Wide-field fundus photograph from neonatal ROP screening.
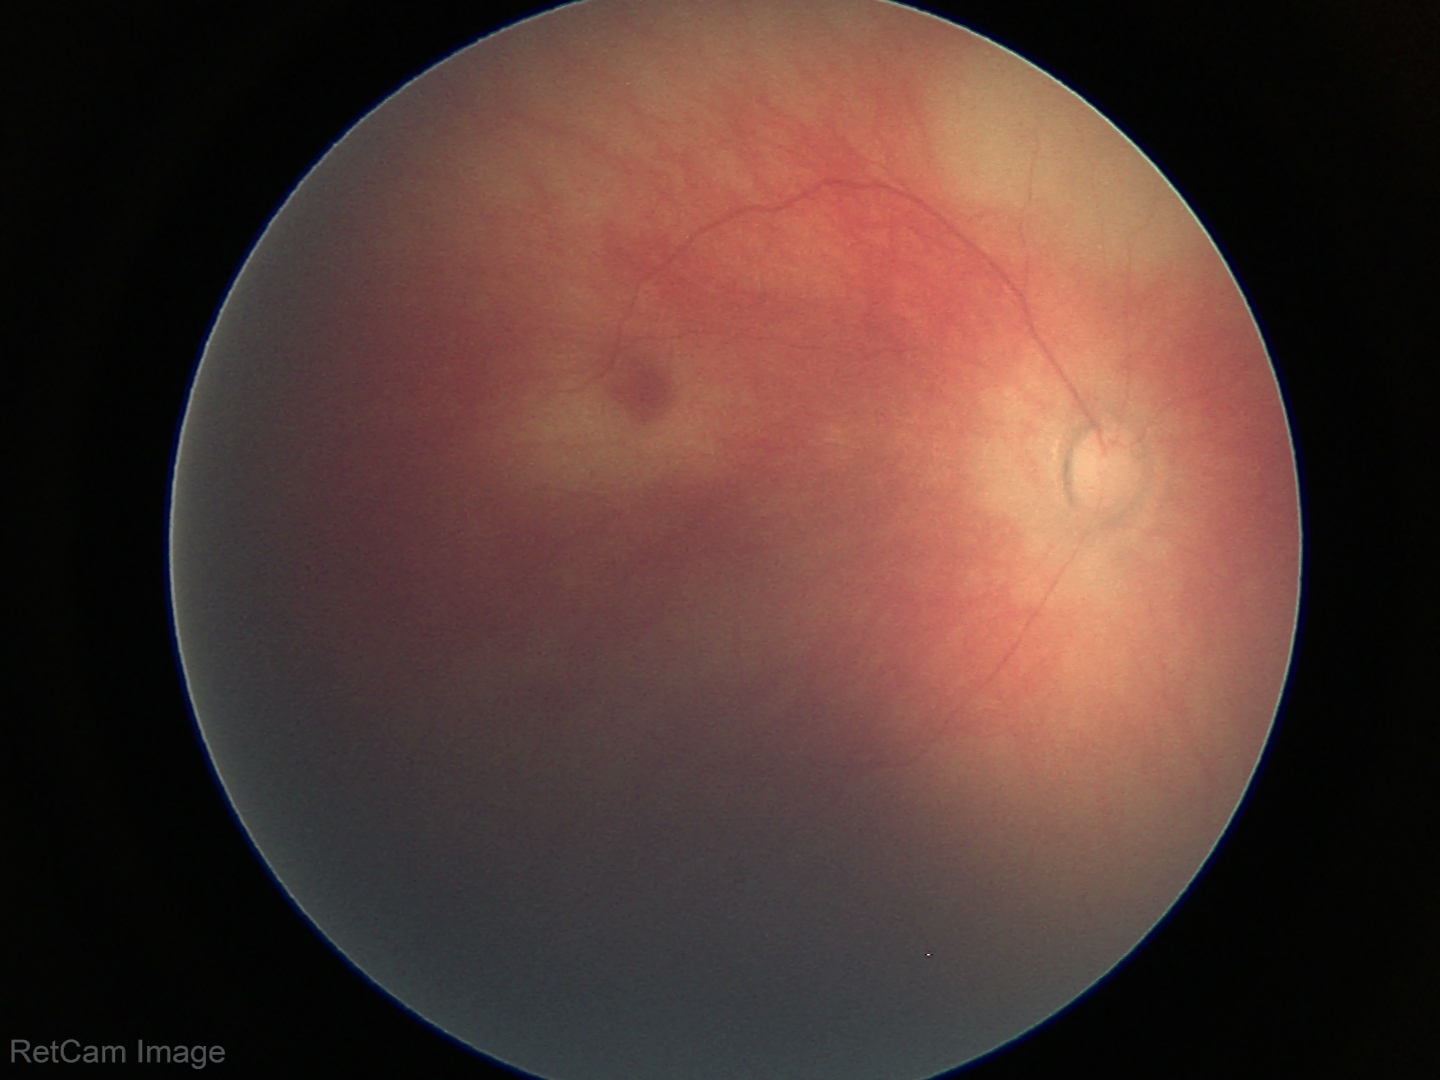 Screening examination with no abnormal retinal findings.